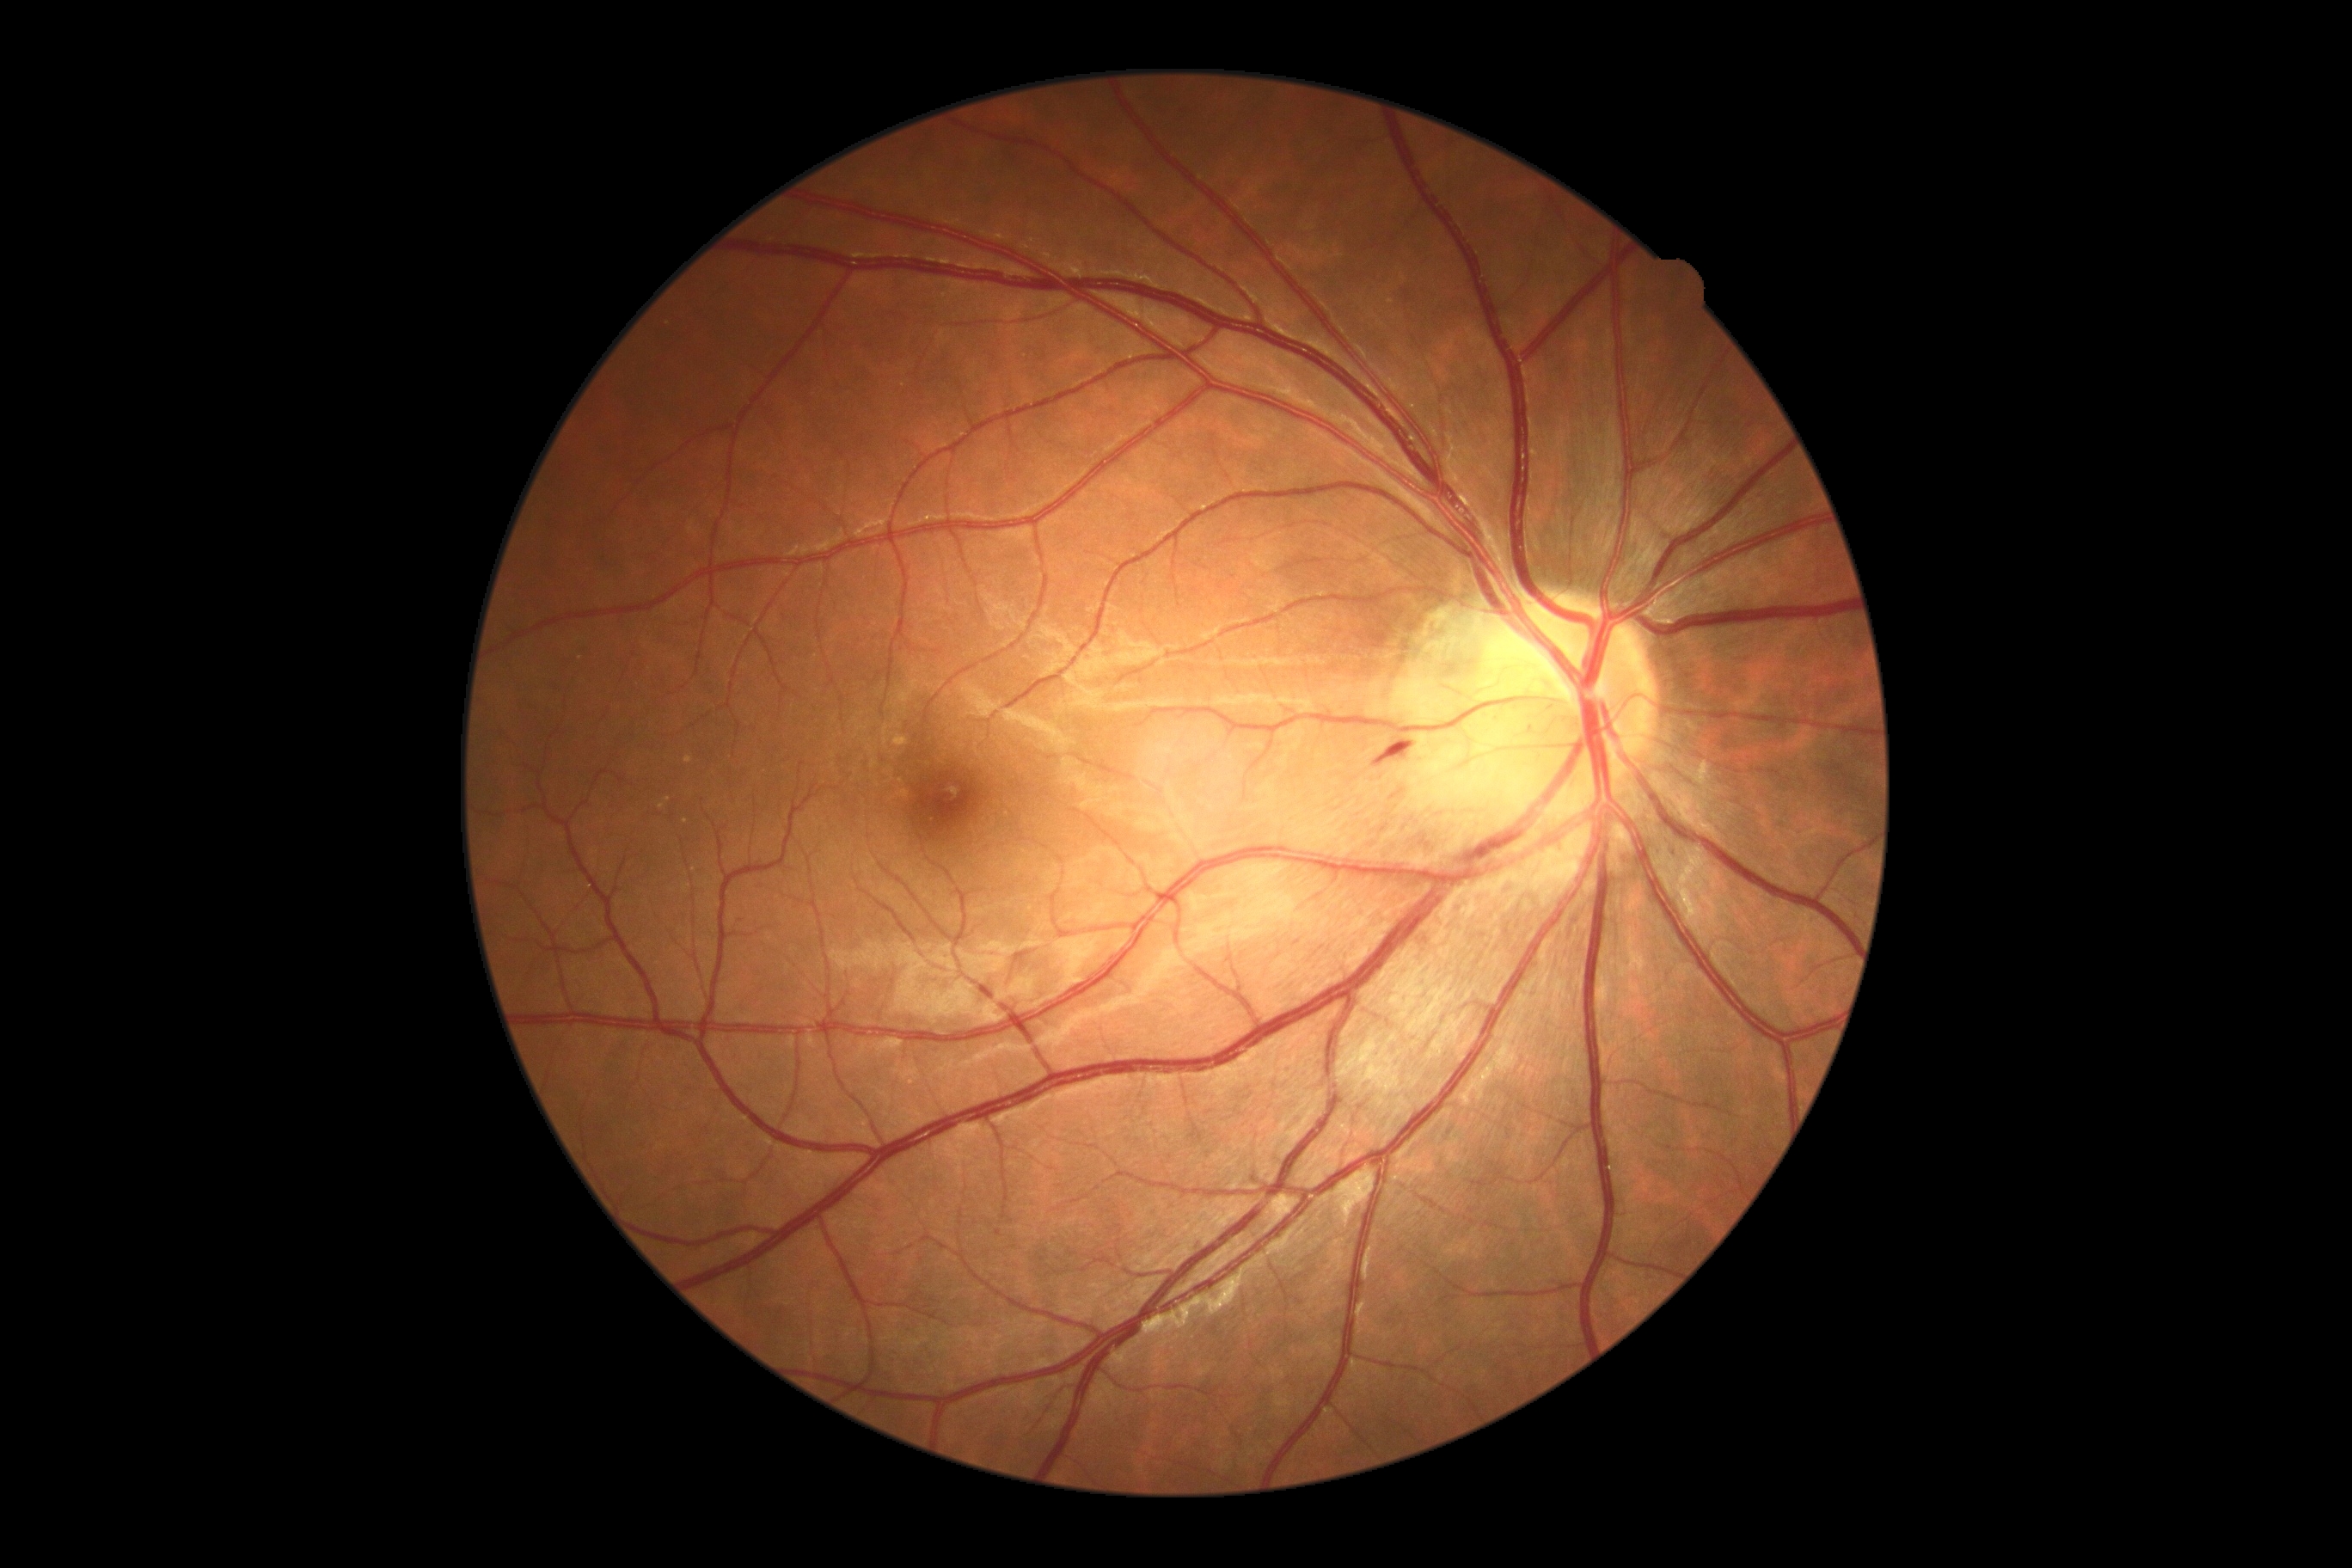 DR stage is grade 2 — more than just microaneurysms but less than severe NPDR.